Phoenix ICON, 100° FOV · infant wide-field fundus photograph · image size 1240x1240.
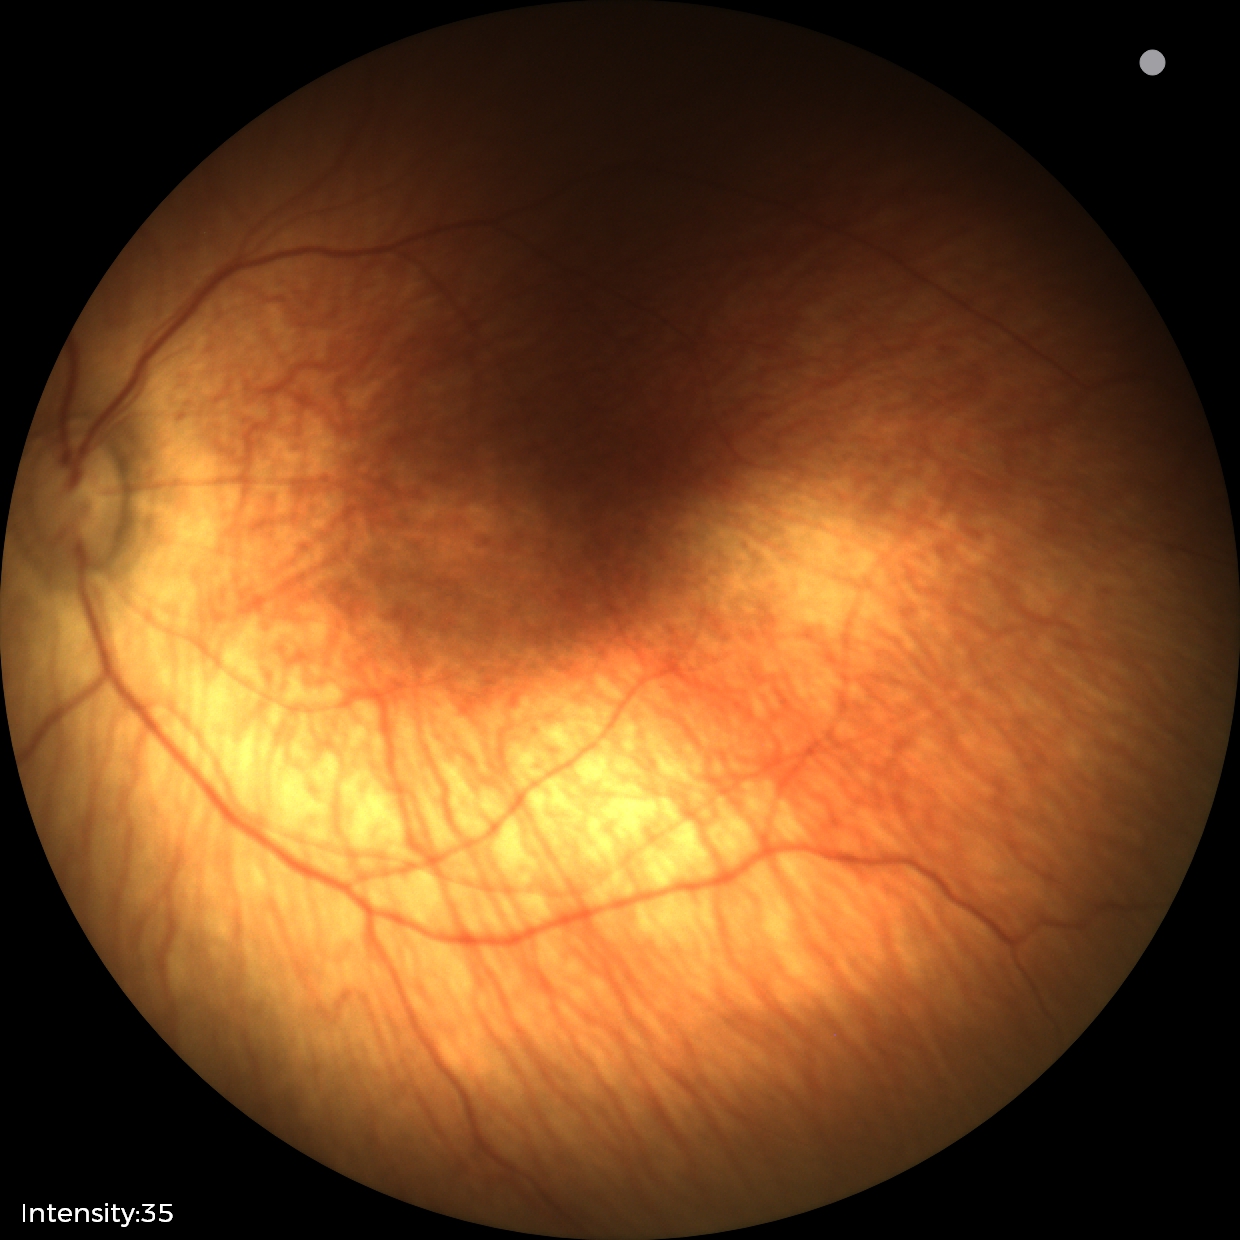

Screening: status post retinopathy of prematurity (ROP).